Color fundus photograph: 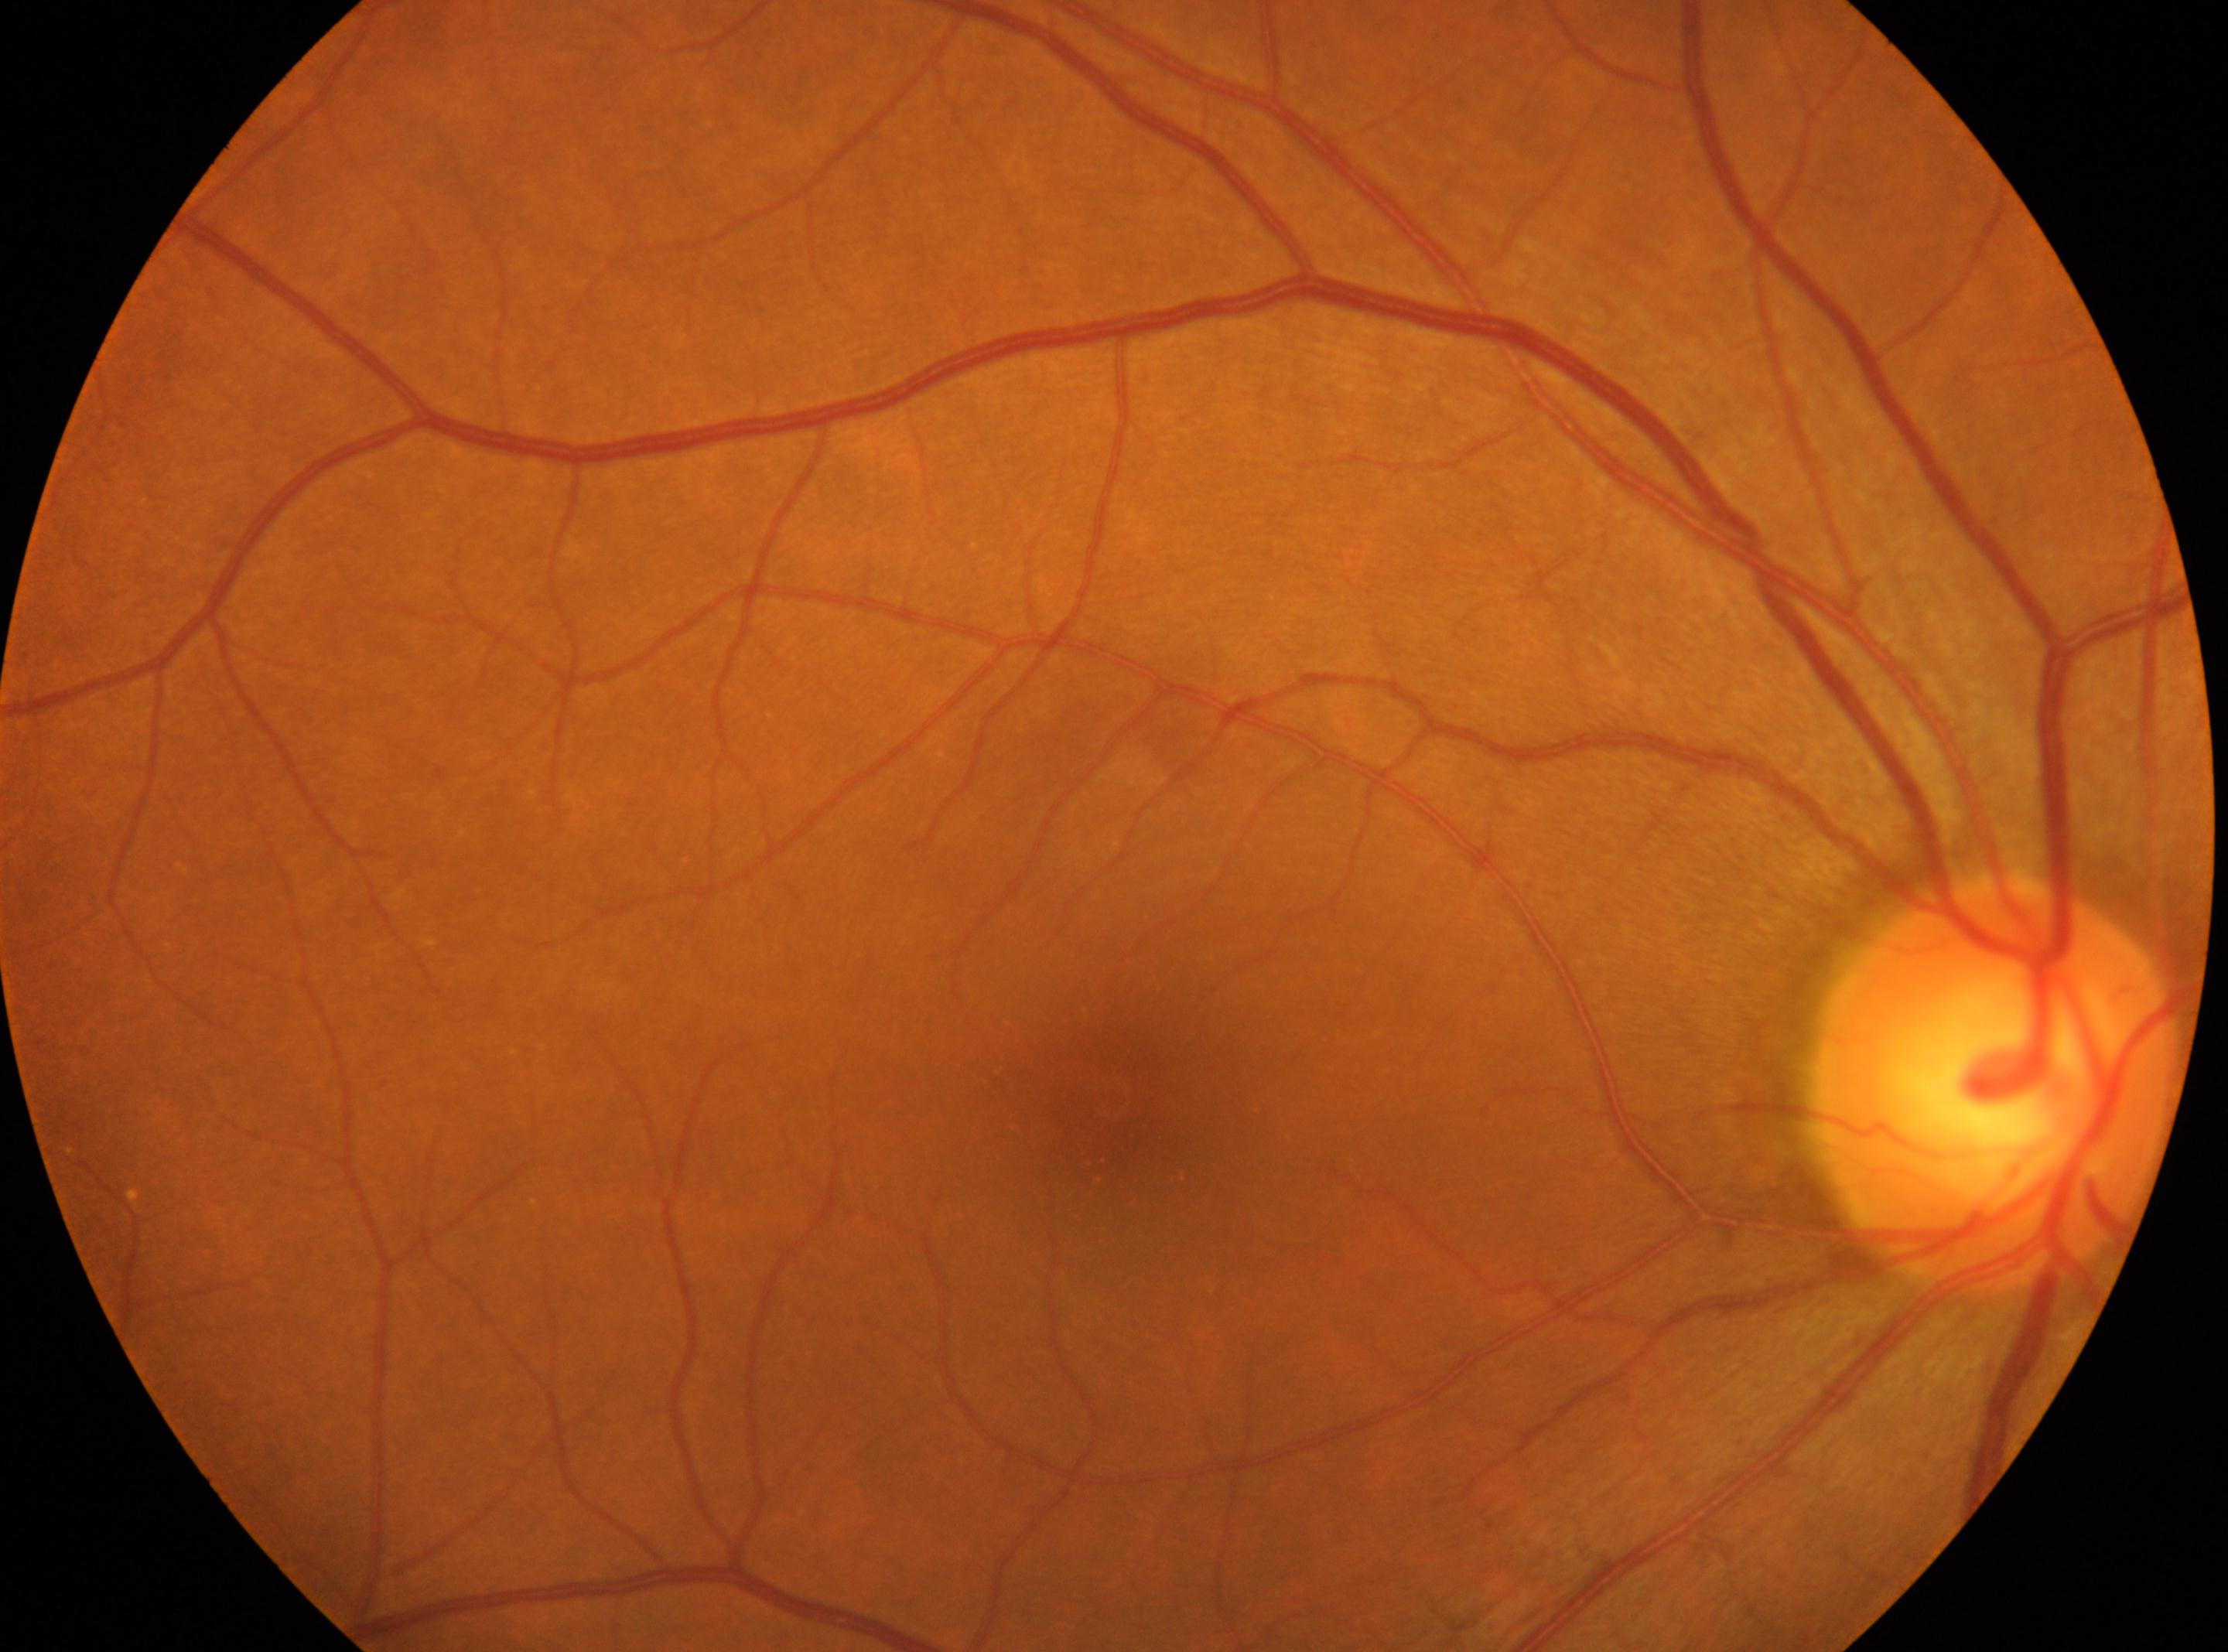

Macula center located at [1112, 1101]. Imaged eye: OD. DR severity is grade 0. ONH: [1994, 1084].